76 years old; IOP 19 mmHg — 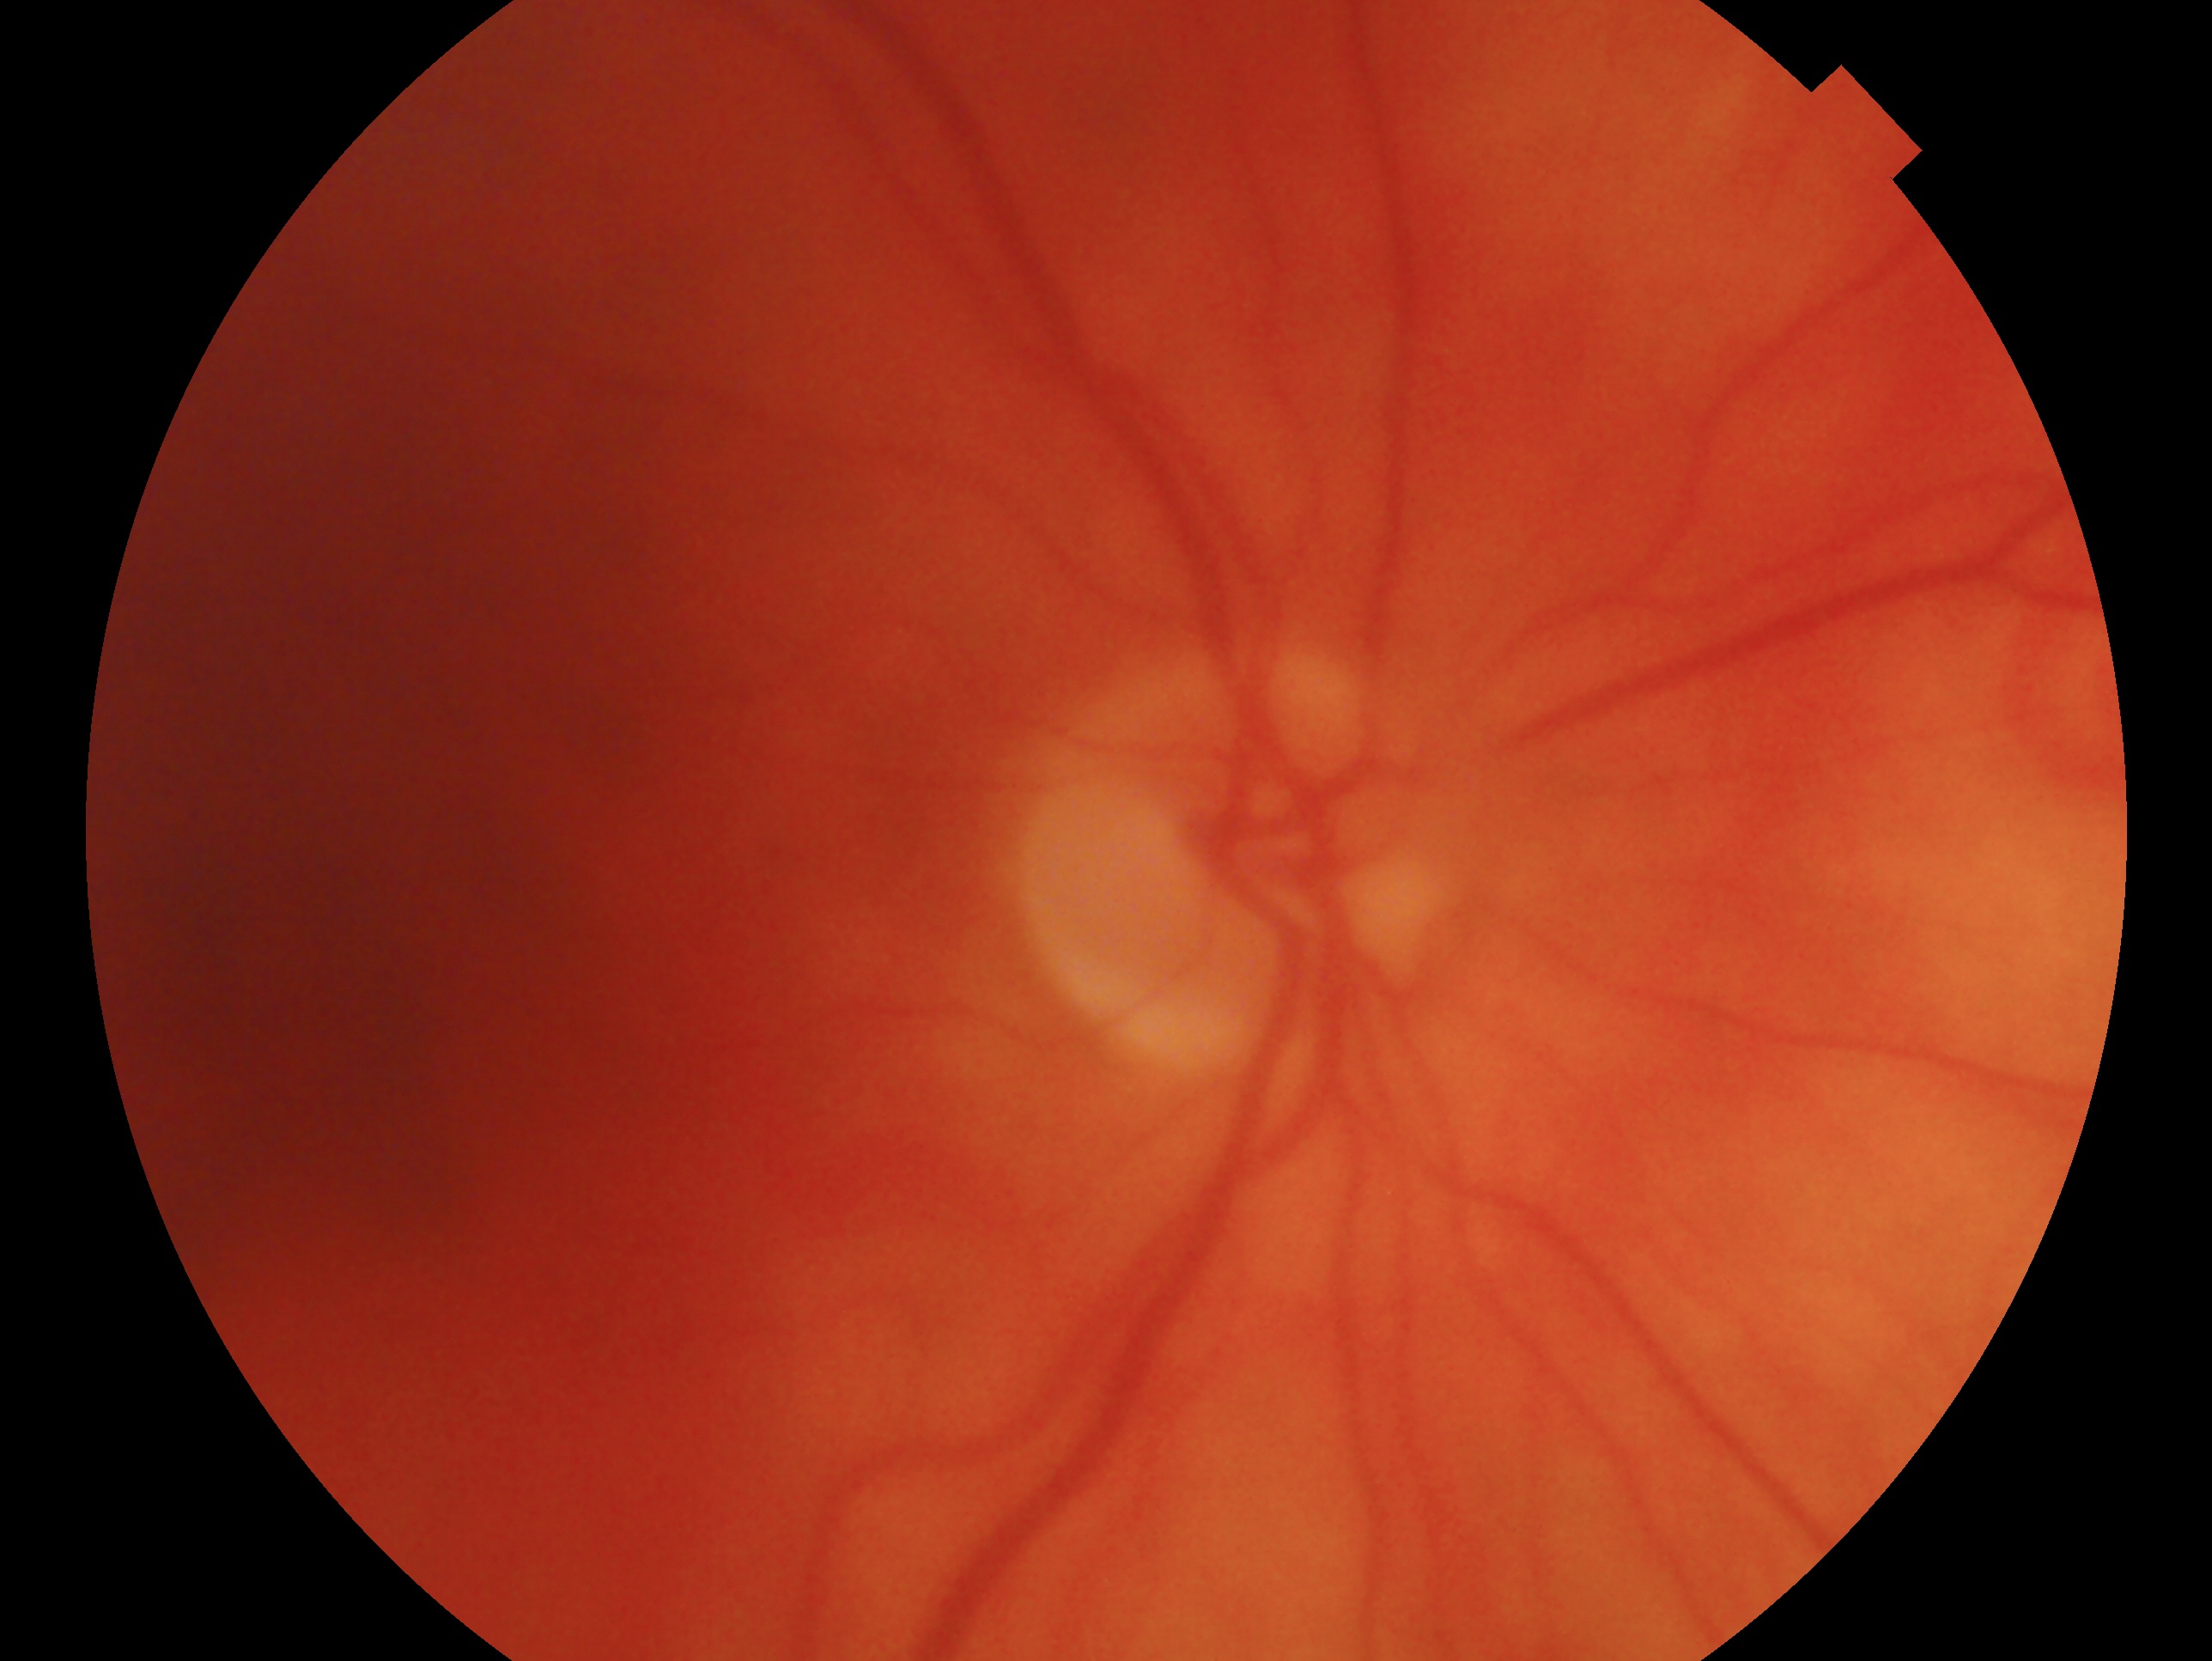

Q: Glaucoma assessment?
A: no signs of glaucoma
Q: Which eye is imaged?
A: right